NIDEK AFC-230; 45° field of view; Davis DR grading; CFP:
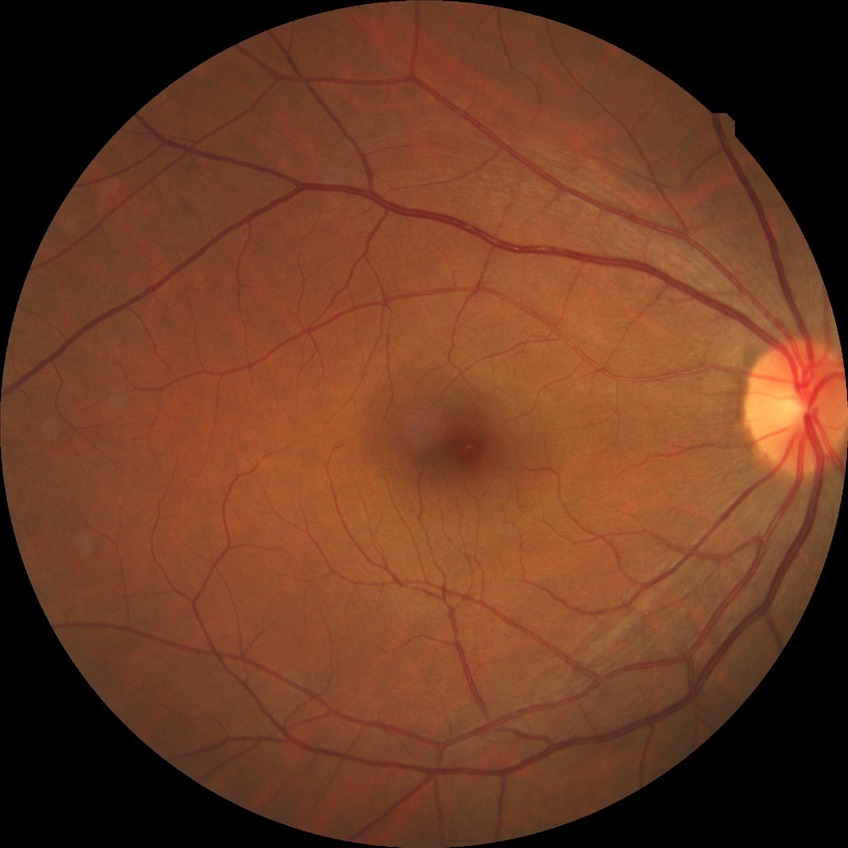
{"davis_grade": "NDR (no diabetic retinopathy)"}